Graded on the modified Davis scale
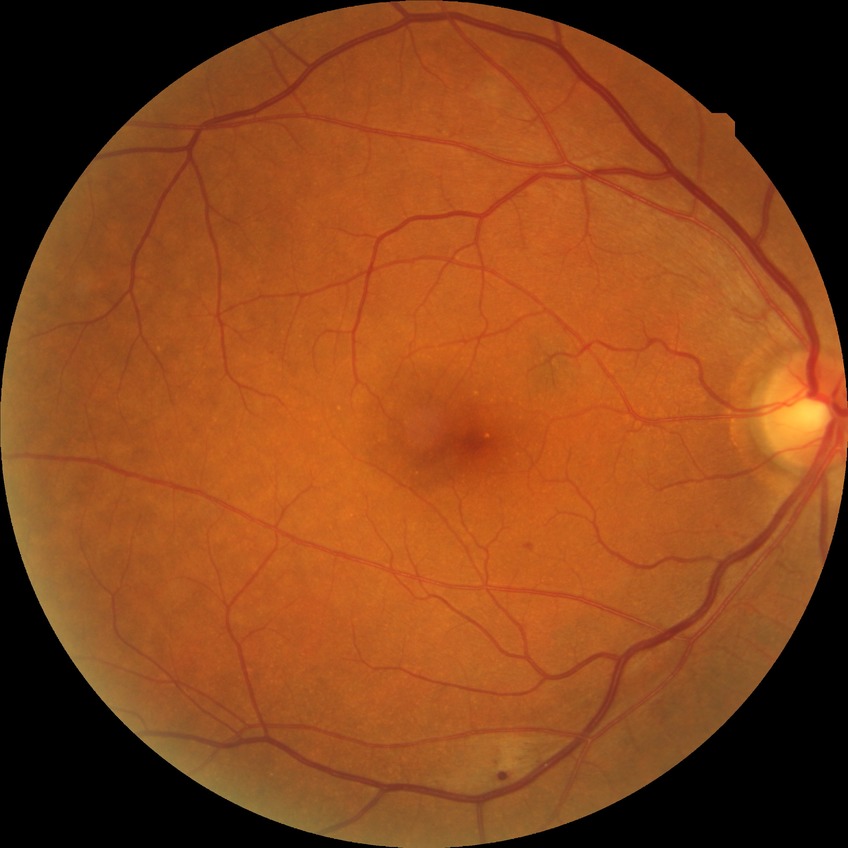
Diabetic retinopathy (DR): PPDR (pre-proliferative diabetic retinopathy). Disease class: non-proliferative diabetic retinopathy.